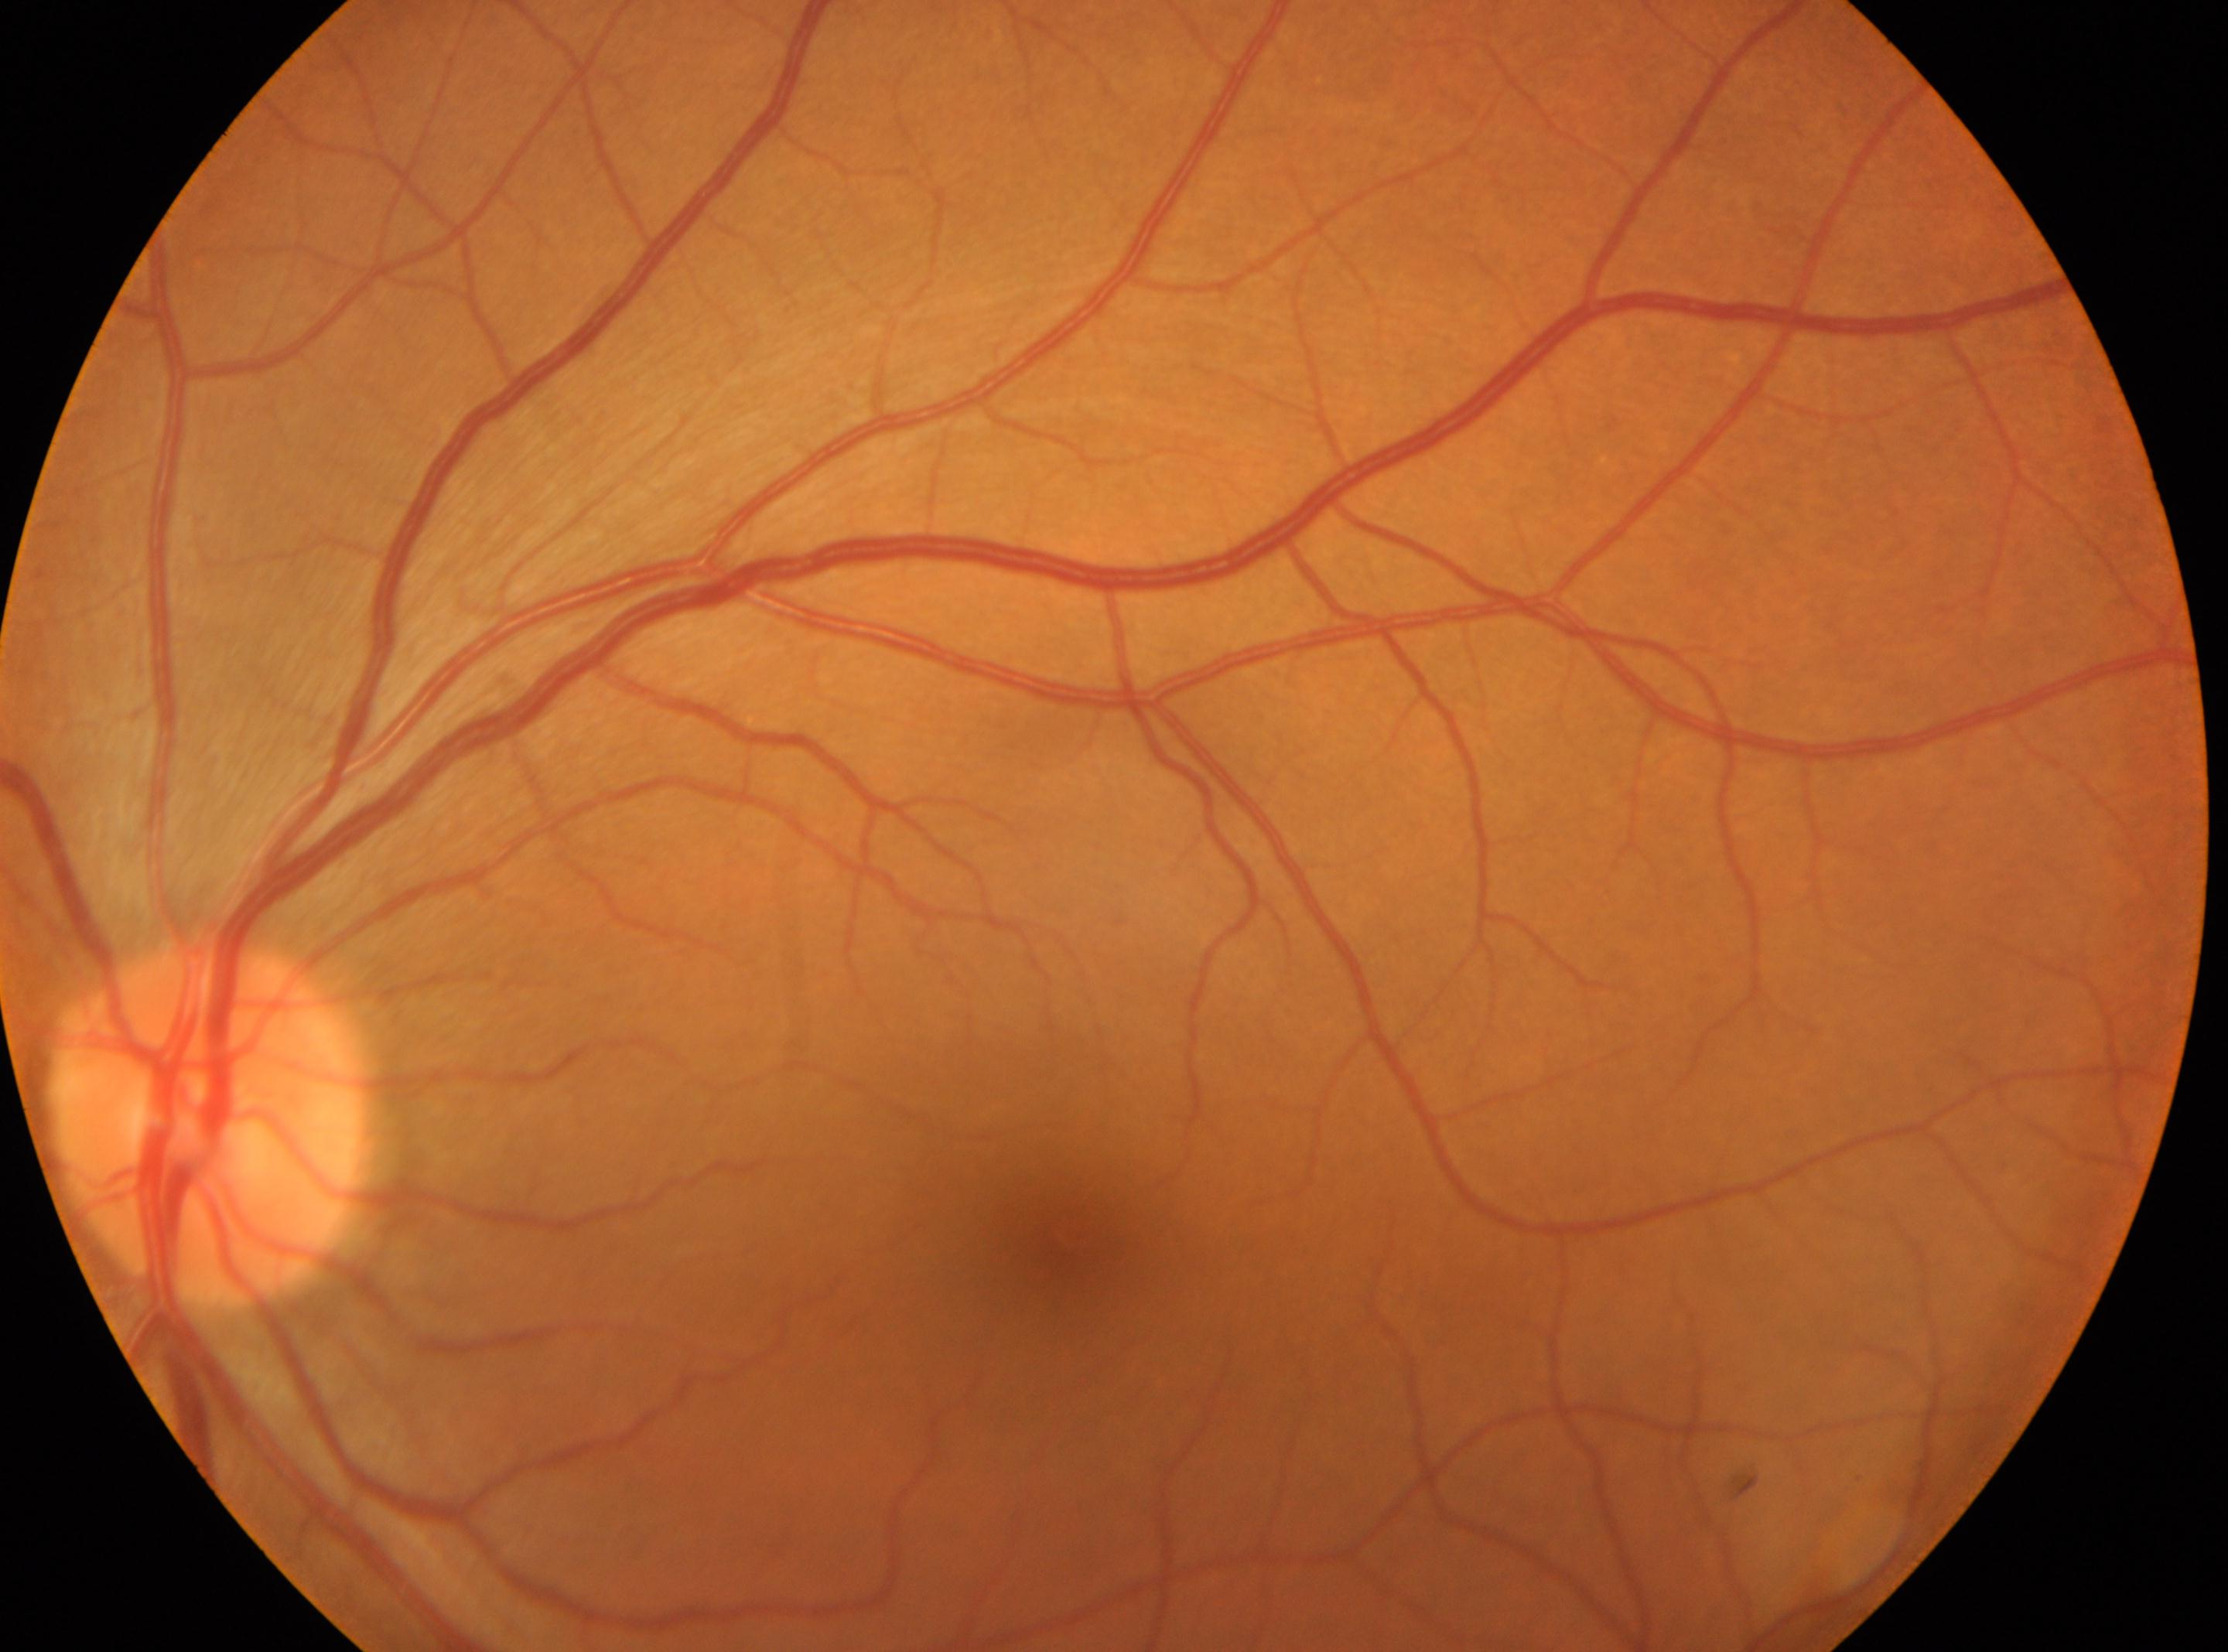
DR severity is grade 0 — no visible signs of diabetic retinopathy. The macular center is at [1064, 1236]. Optic disk: [206, 1125]. Eye: left.